Infant wide-field retinal image — 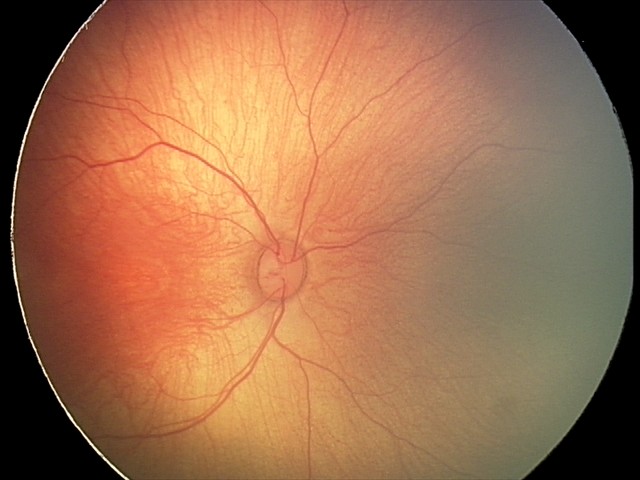

Assessment = retinal hemorrhages